Nonmydriatic fundus photograph
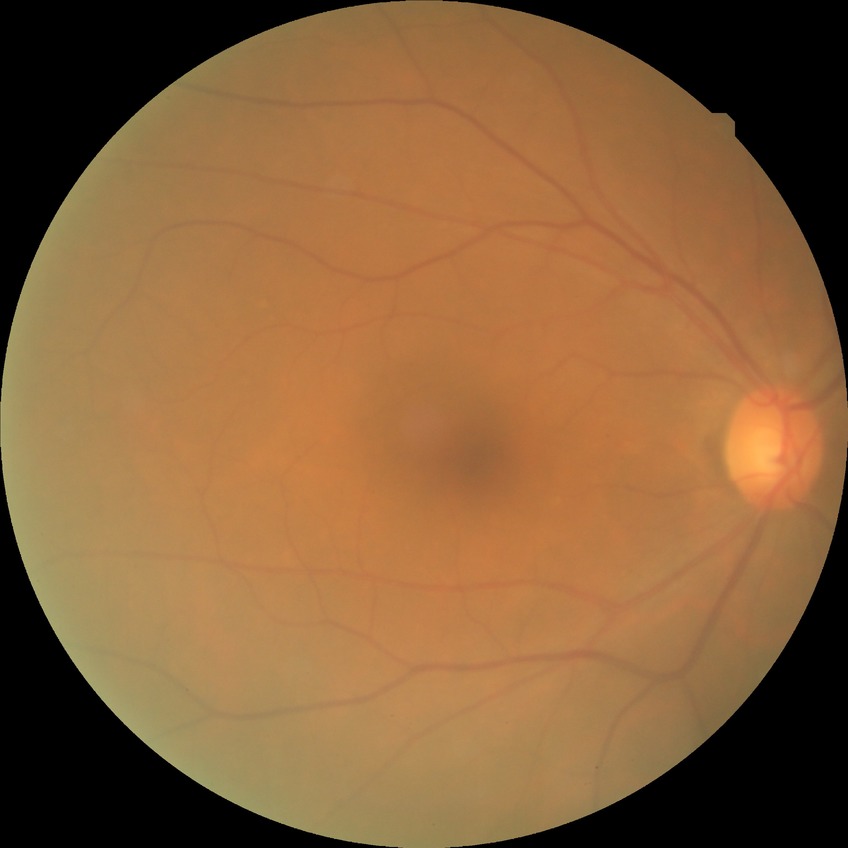

DR is NDR.